50° FOV
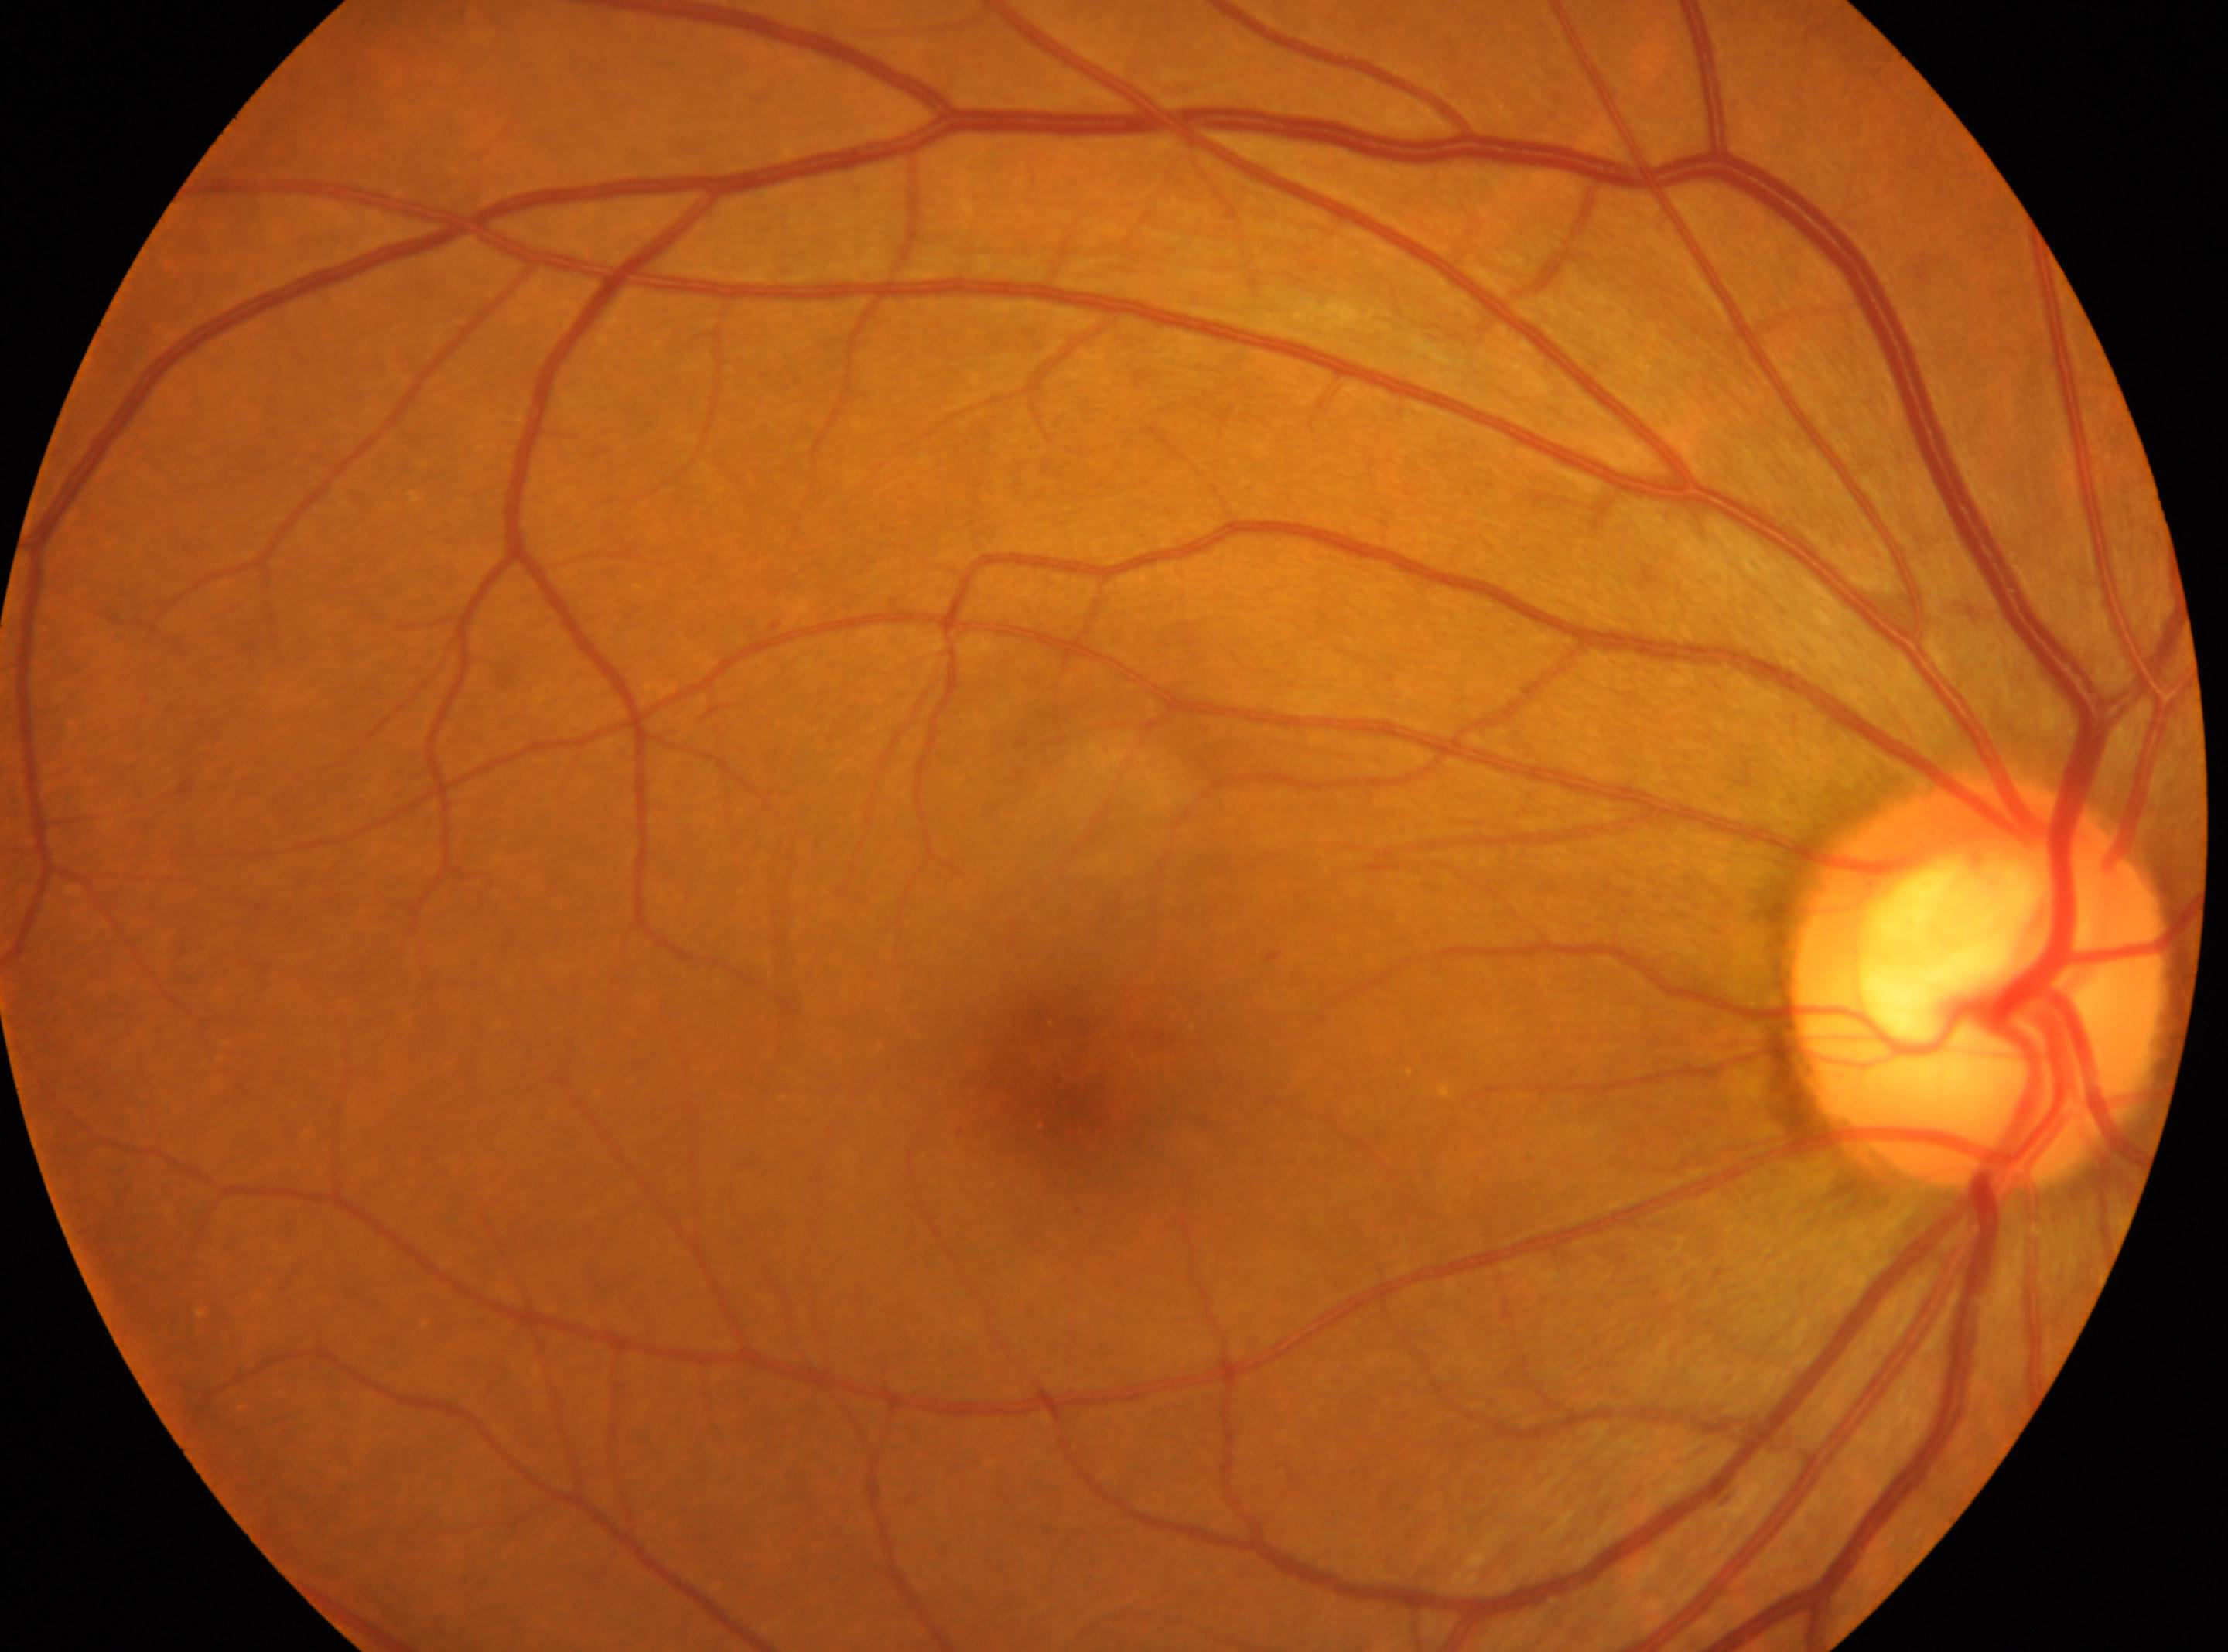
Imaged eye: OD. Diabetic retinopathy grade is 1/4. Disc center located at 1977, 985. Fovea: 1054, 1089.